2212x1659px.
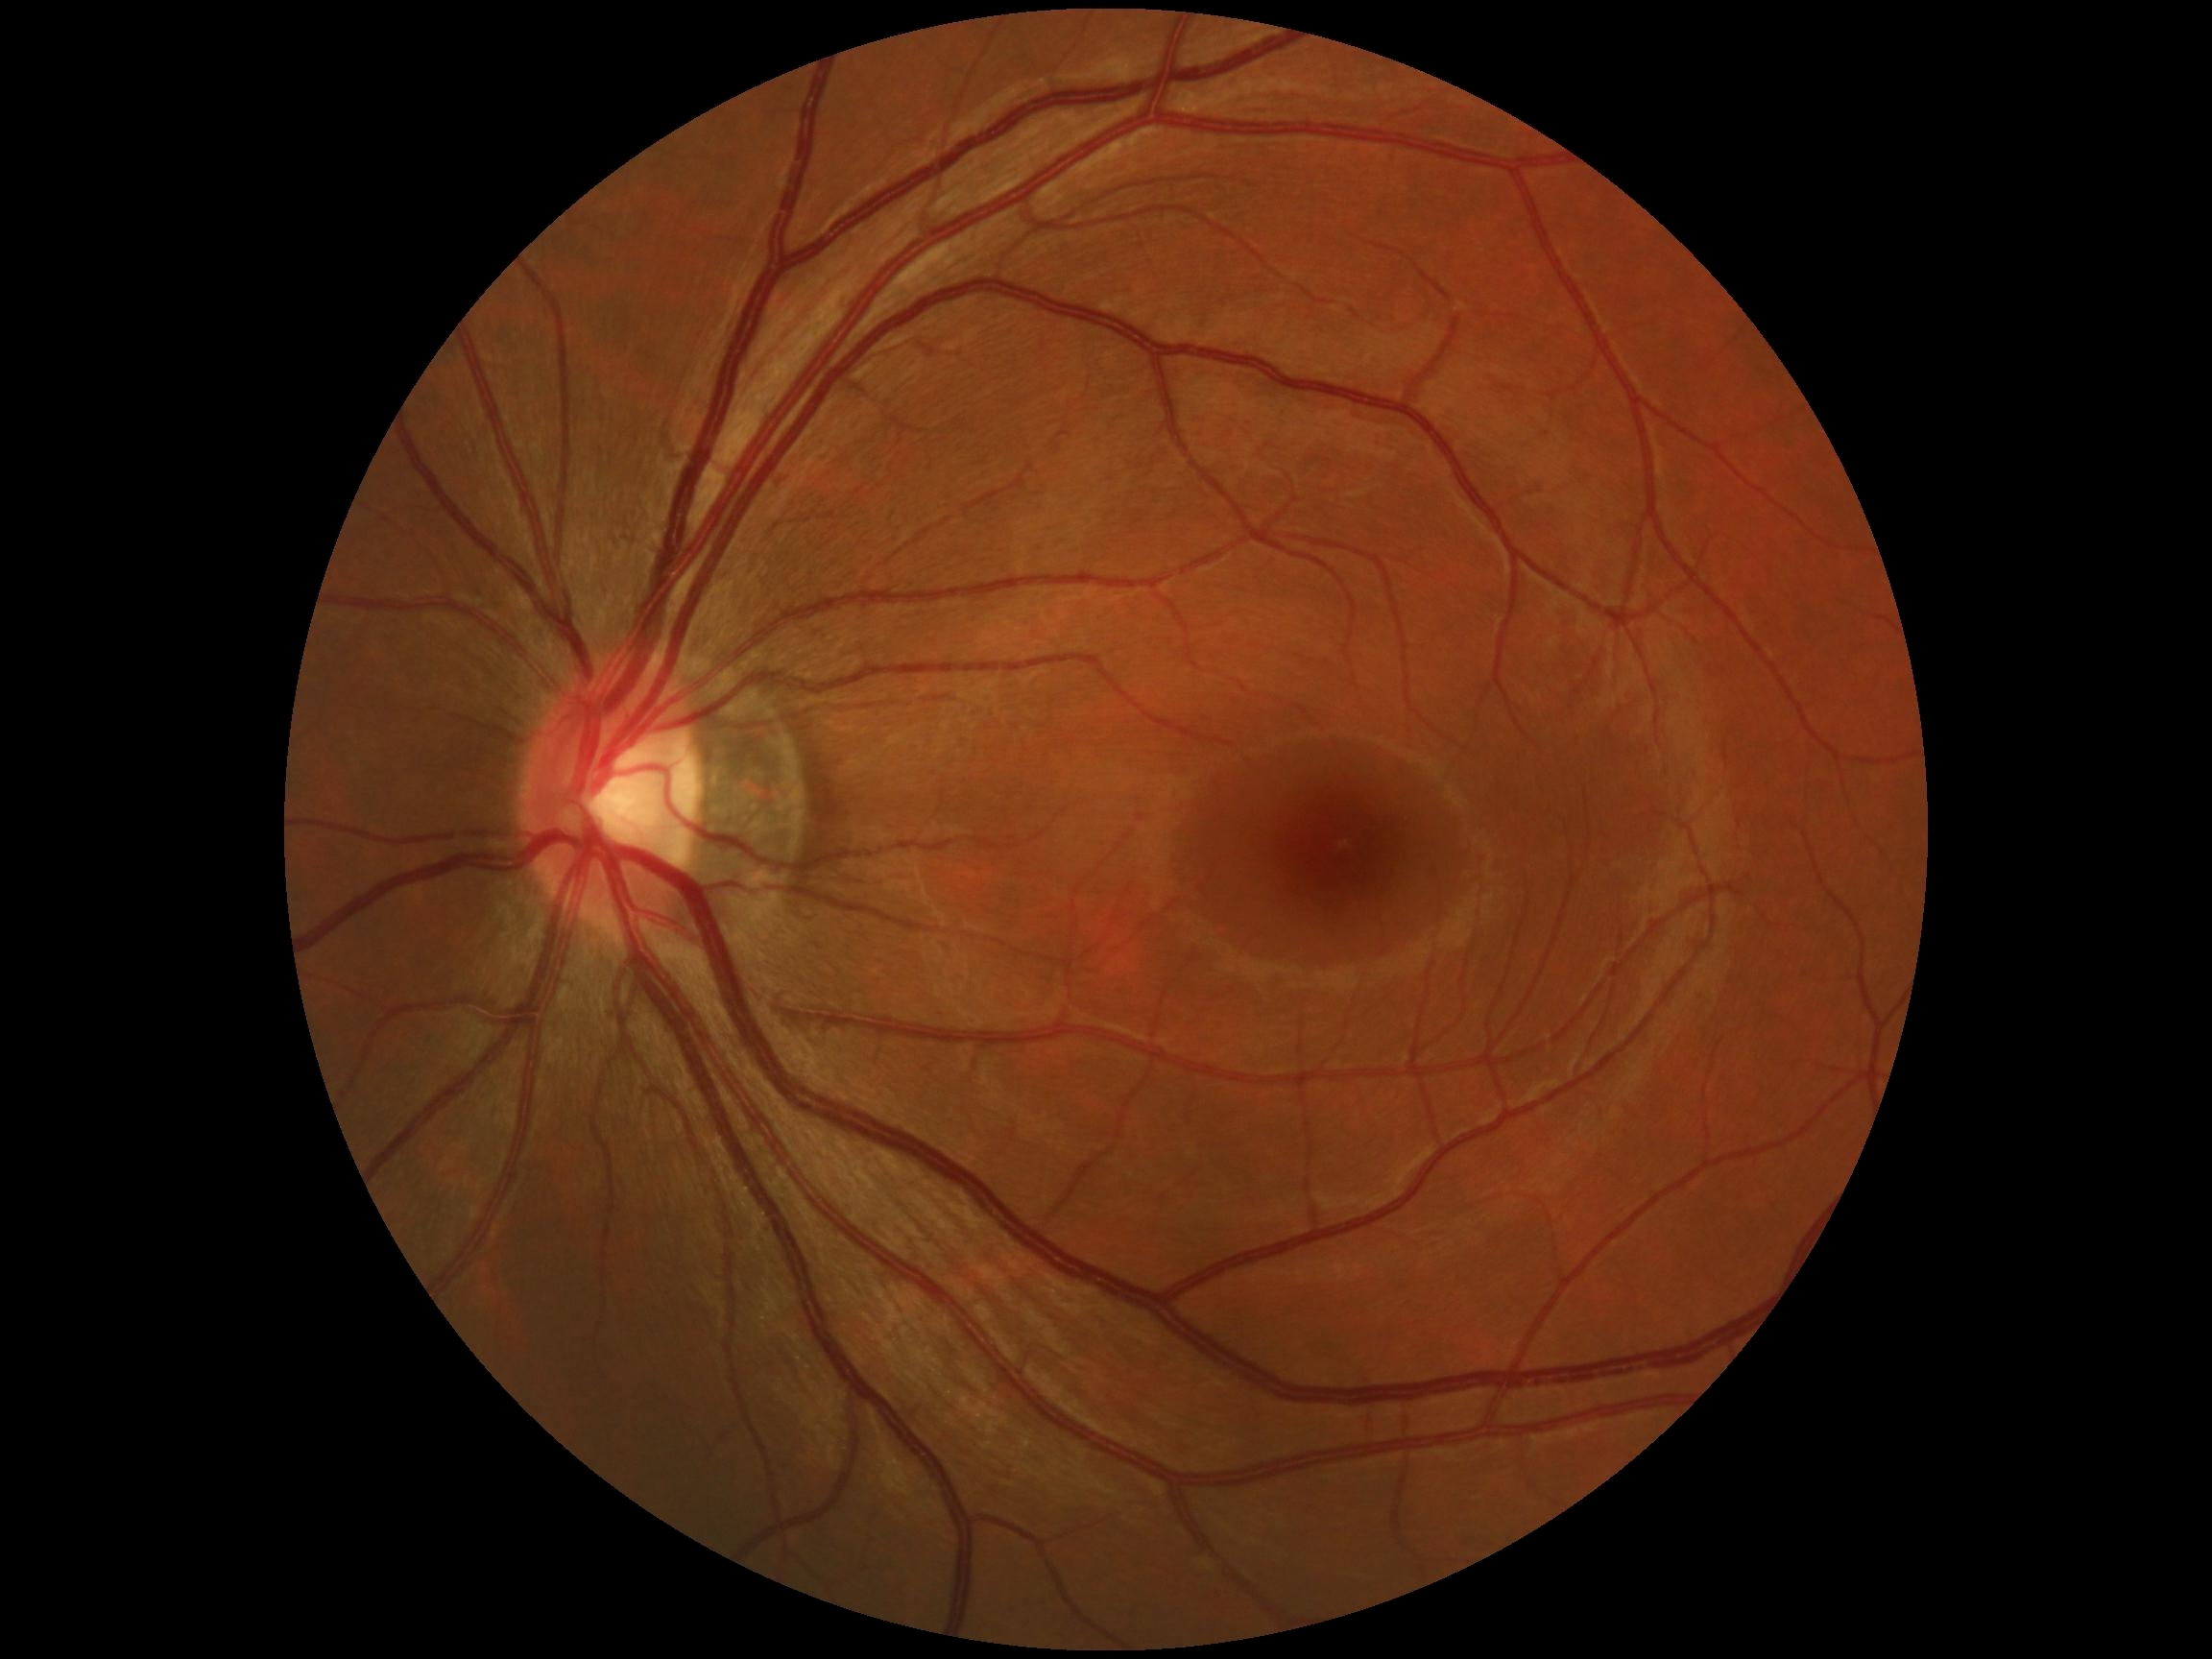
DR grade=no apparent retinopathy (0).